Pediatric retinal photograph (wide-field): 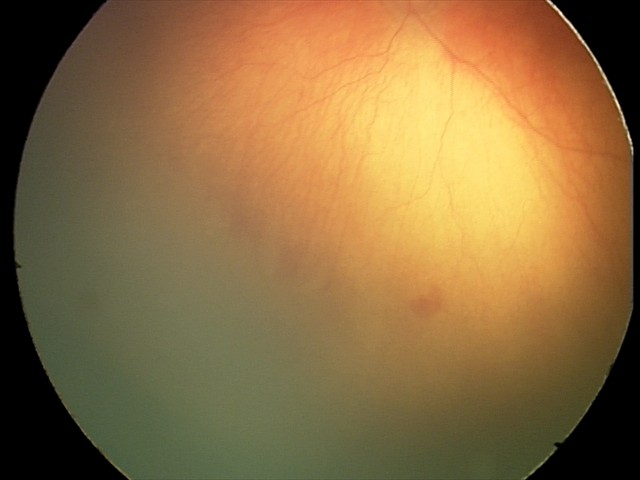
With plus disease. Screening series with aggressive ROP (A-ROP).